Acquired with a NIDEK AFC-230, diabetic retinopathy graded by the modified Davis classification, posterior pole photograph.
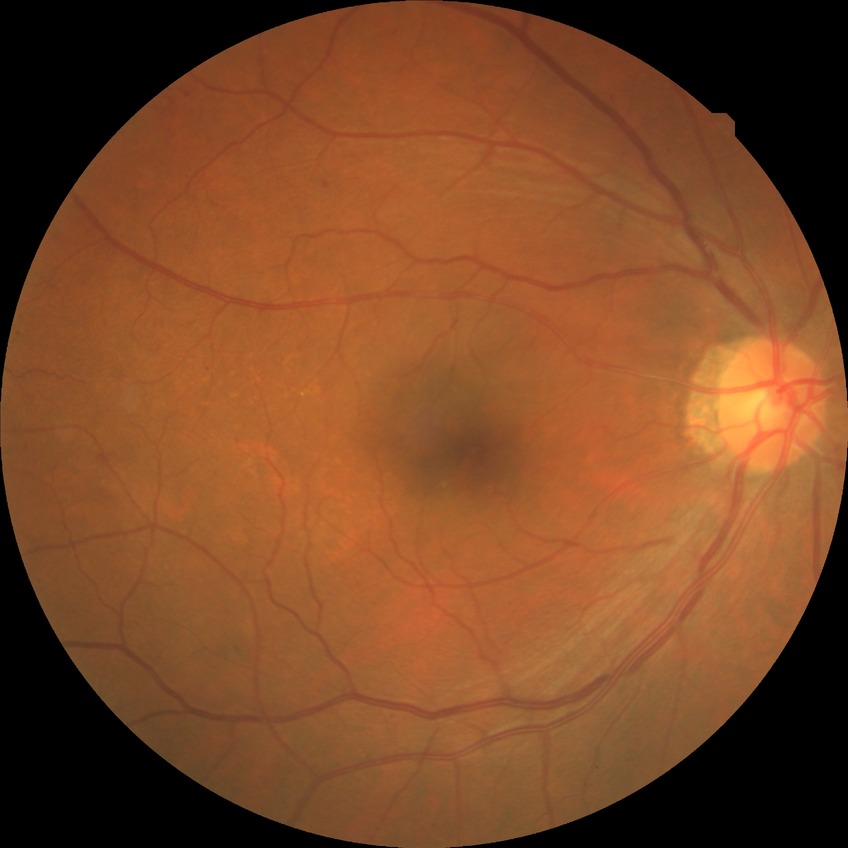 The retinopathy is classified as non-proliferative diabetic retinopathy. Davis grading is simple diabetic retinopathy.